Infant wide-field retinal image: 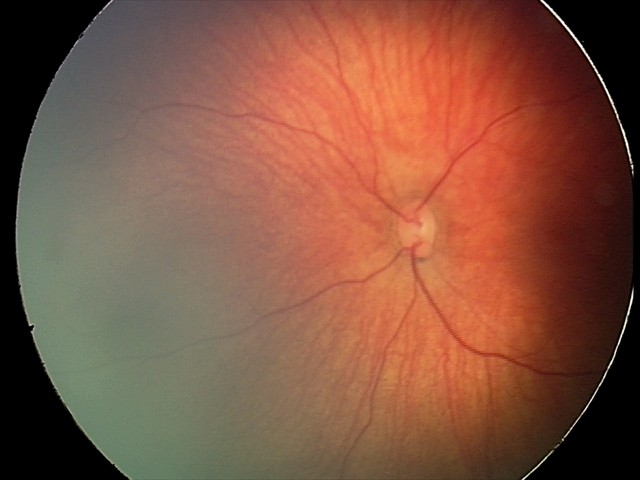

Examination diagnosed as retinal hemorrhages.